45° field of view.
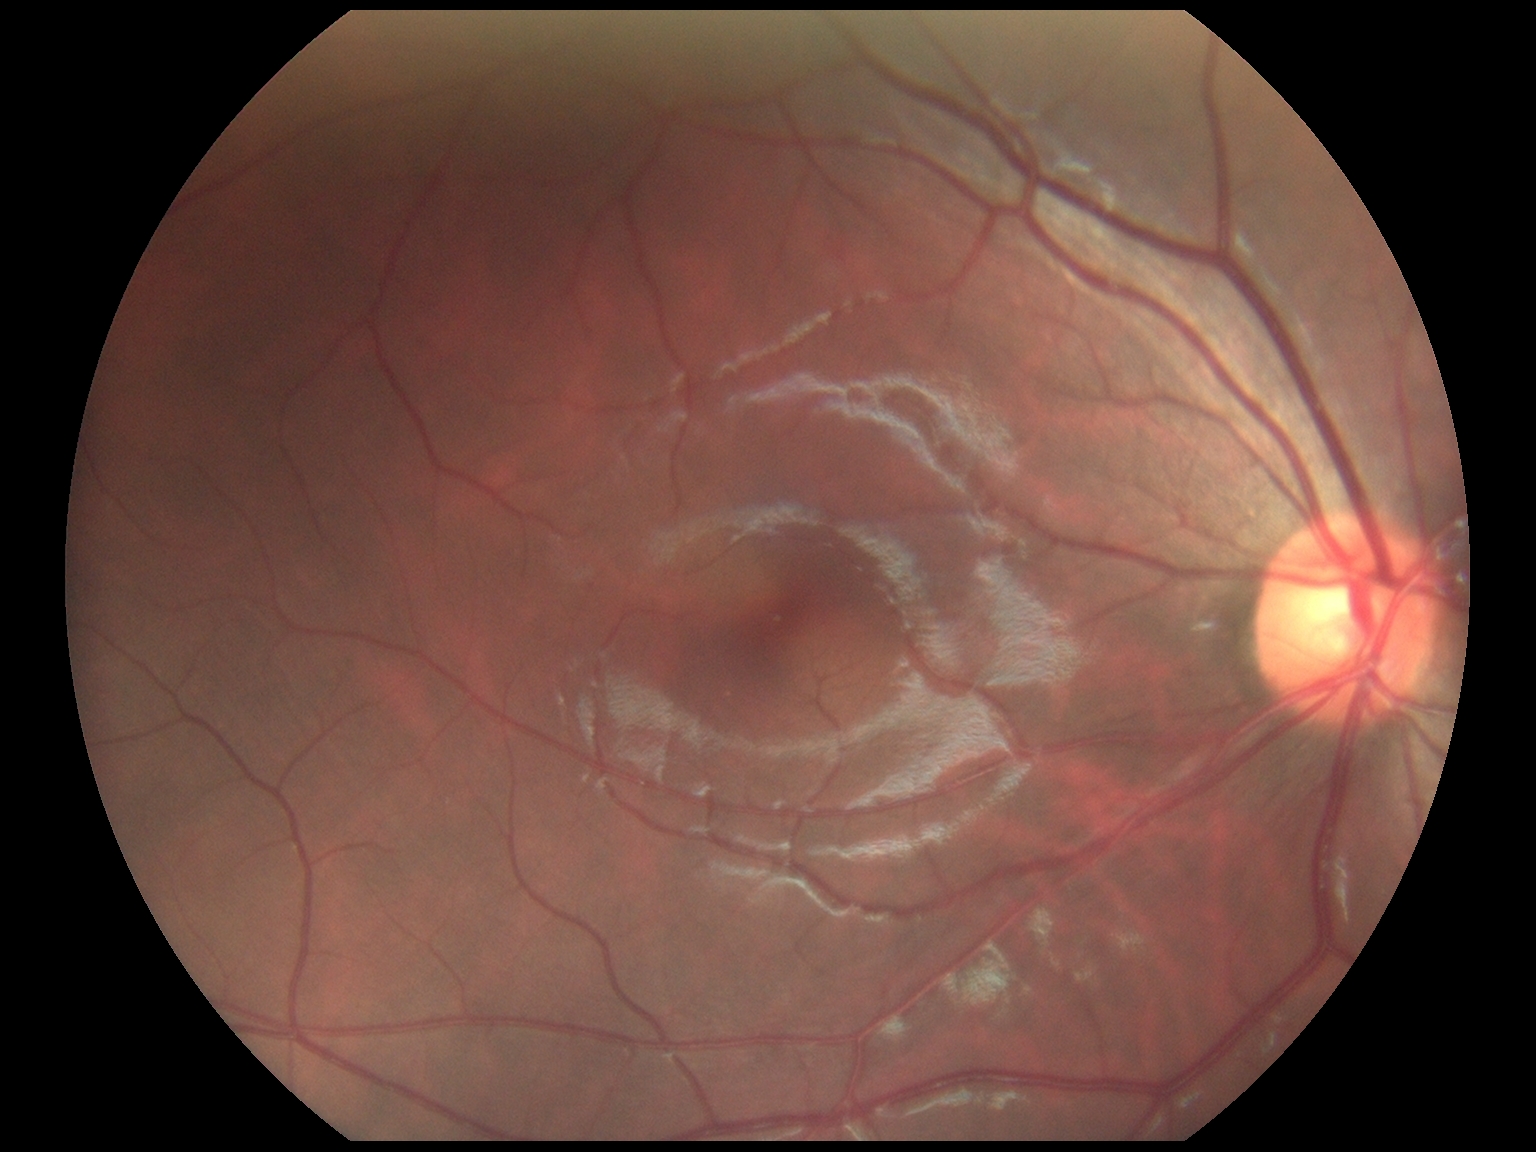

Diabetic retinopathy grade is no apparent diabetic retinopathy (0). No DR findings.